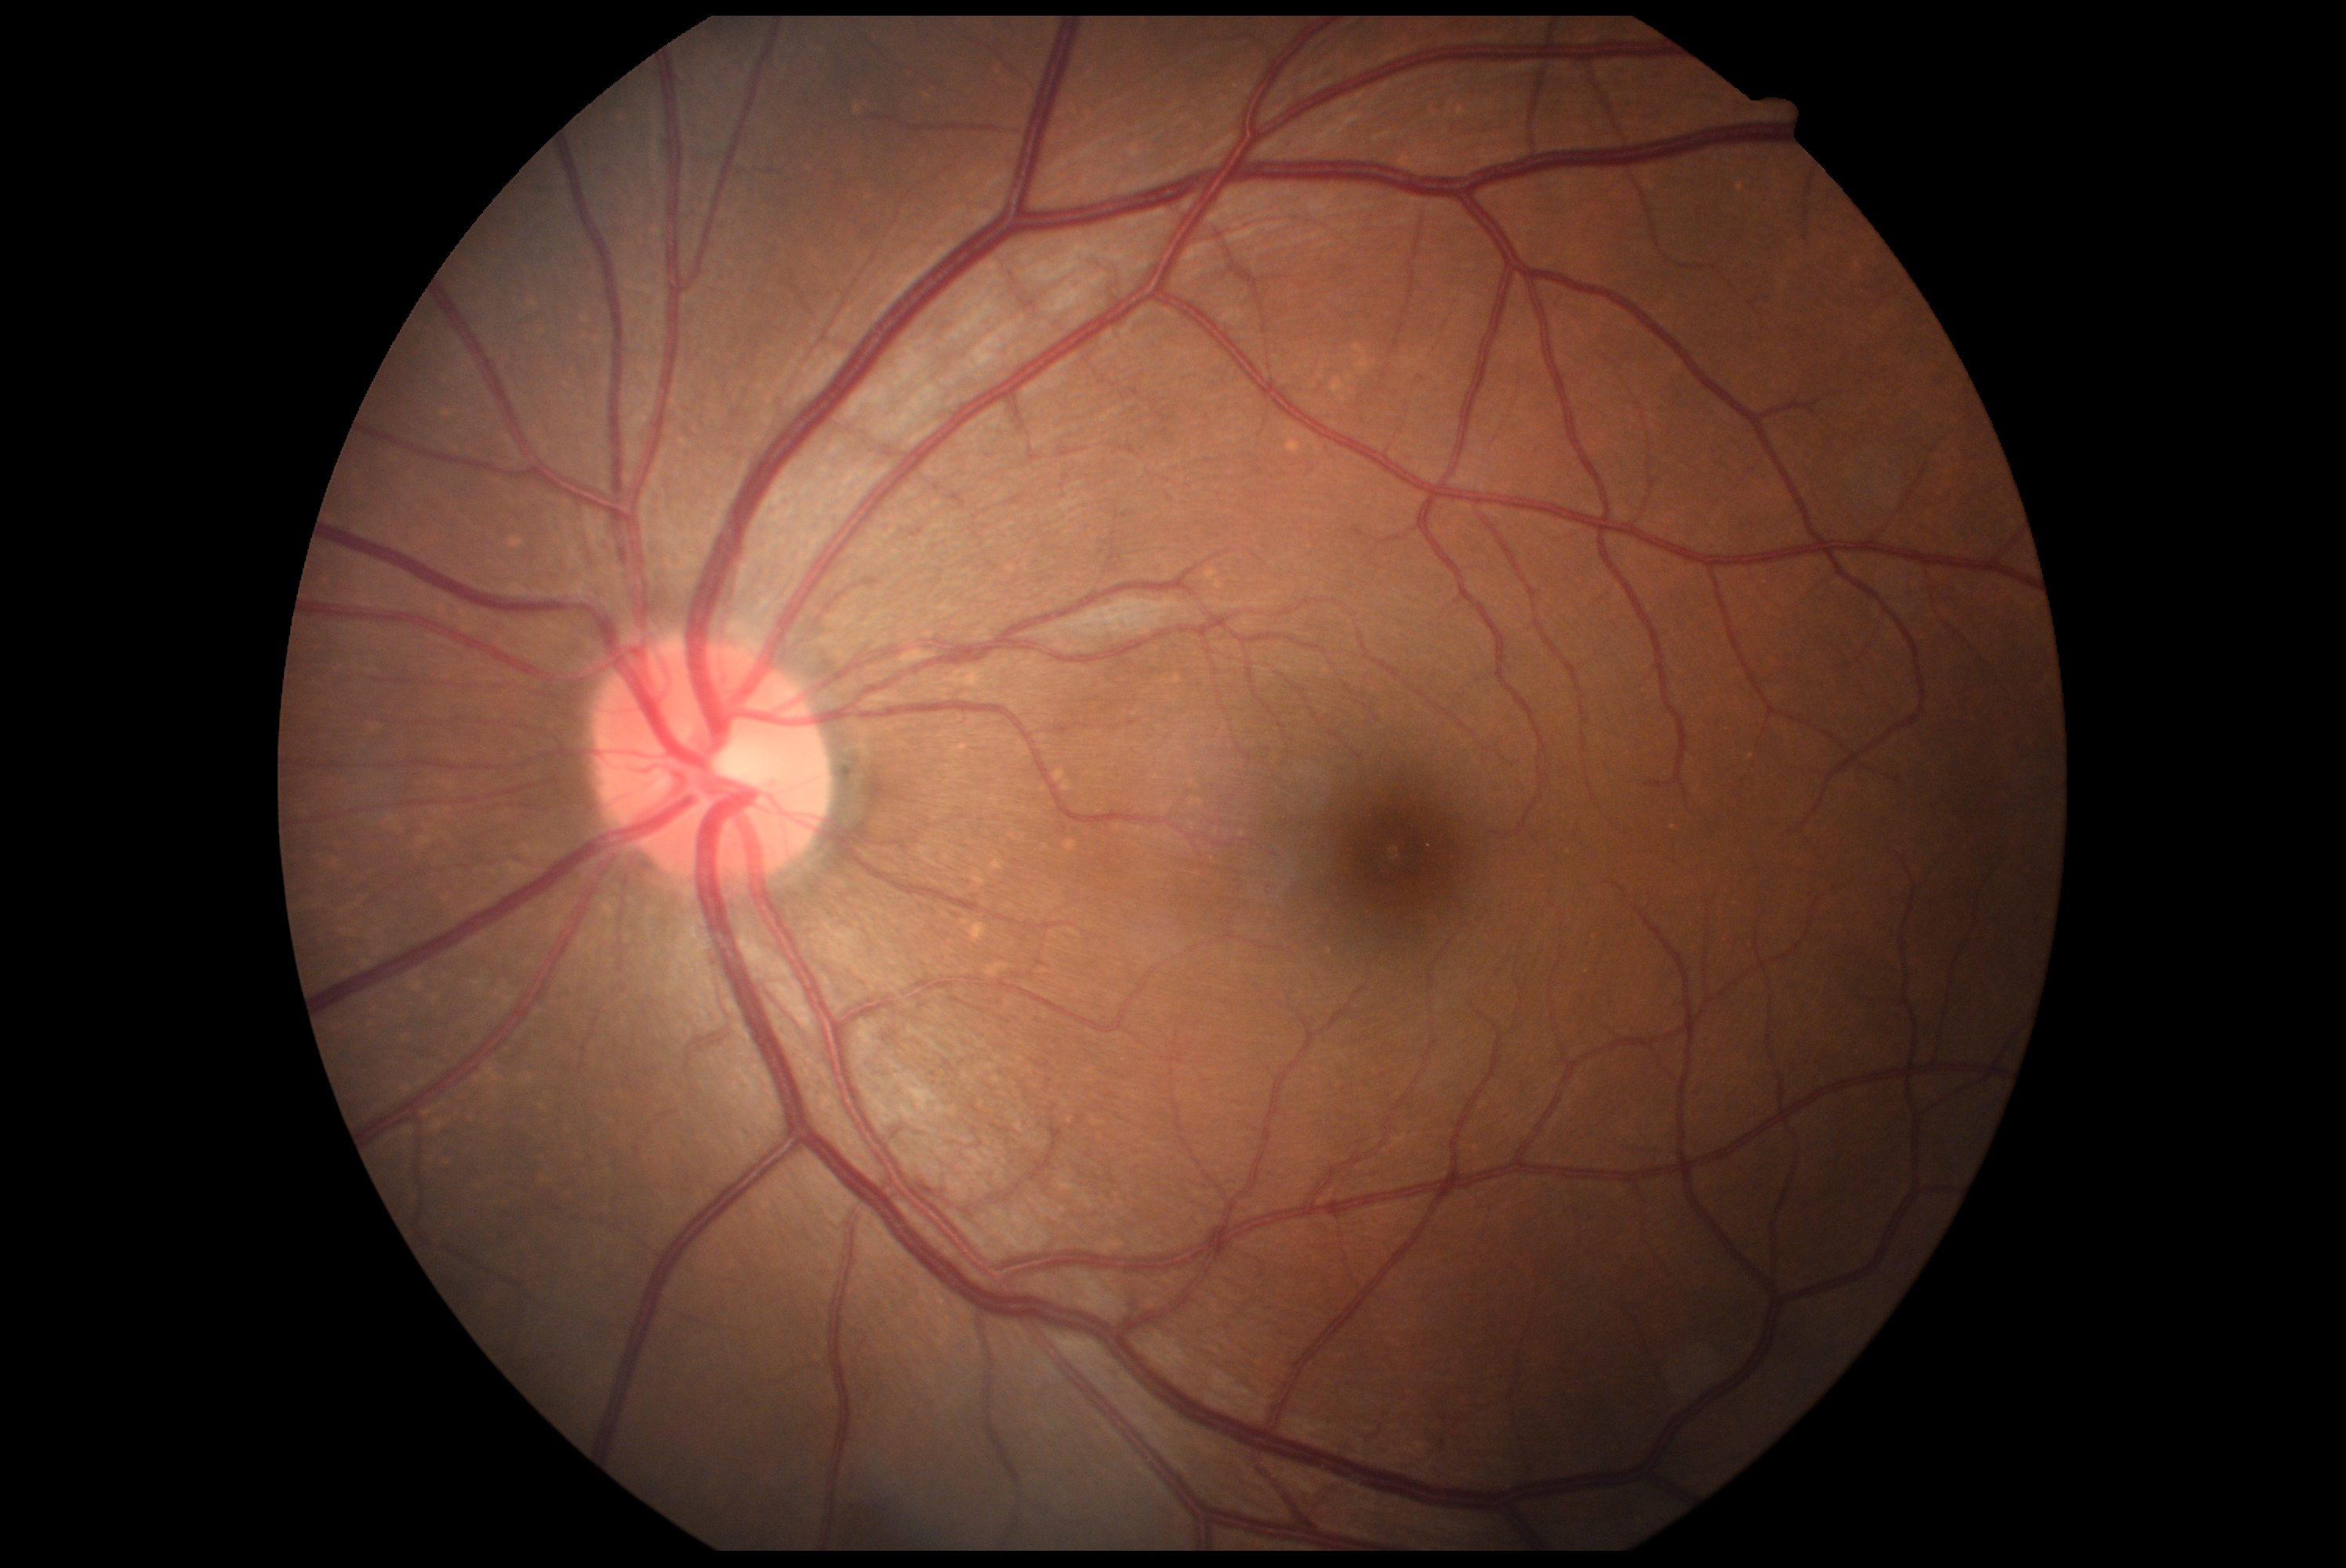

DR impression: no apparent DR
DR stage: grade 0